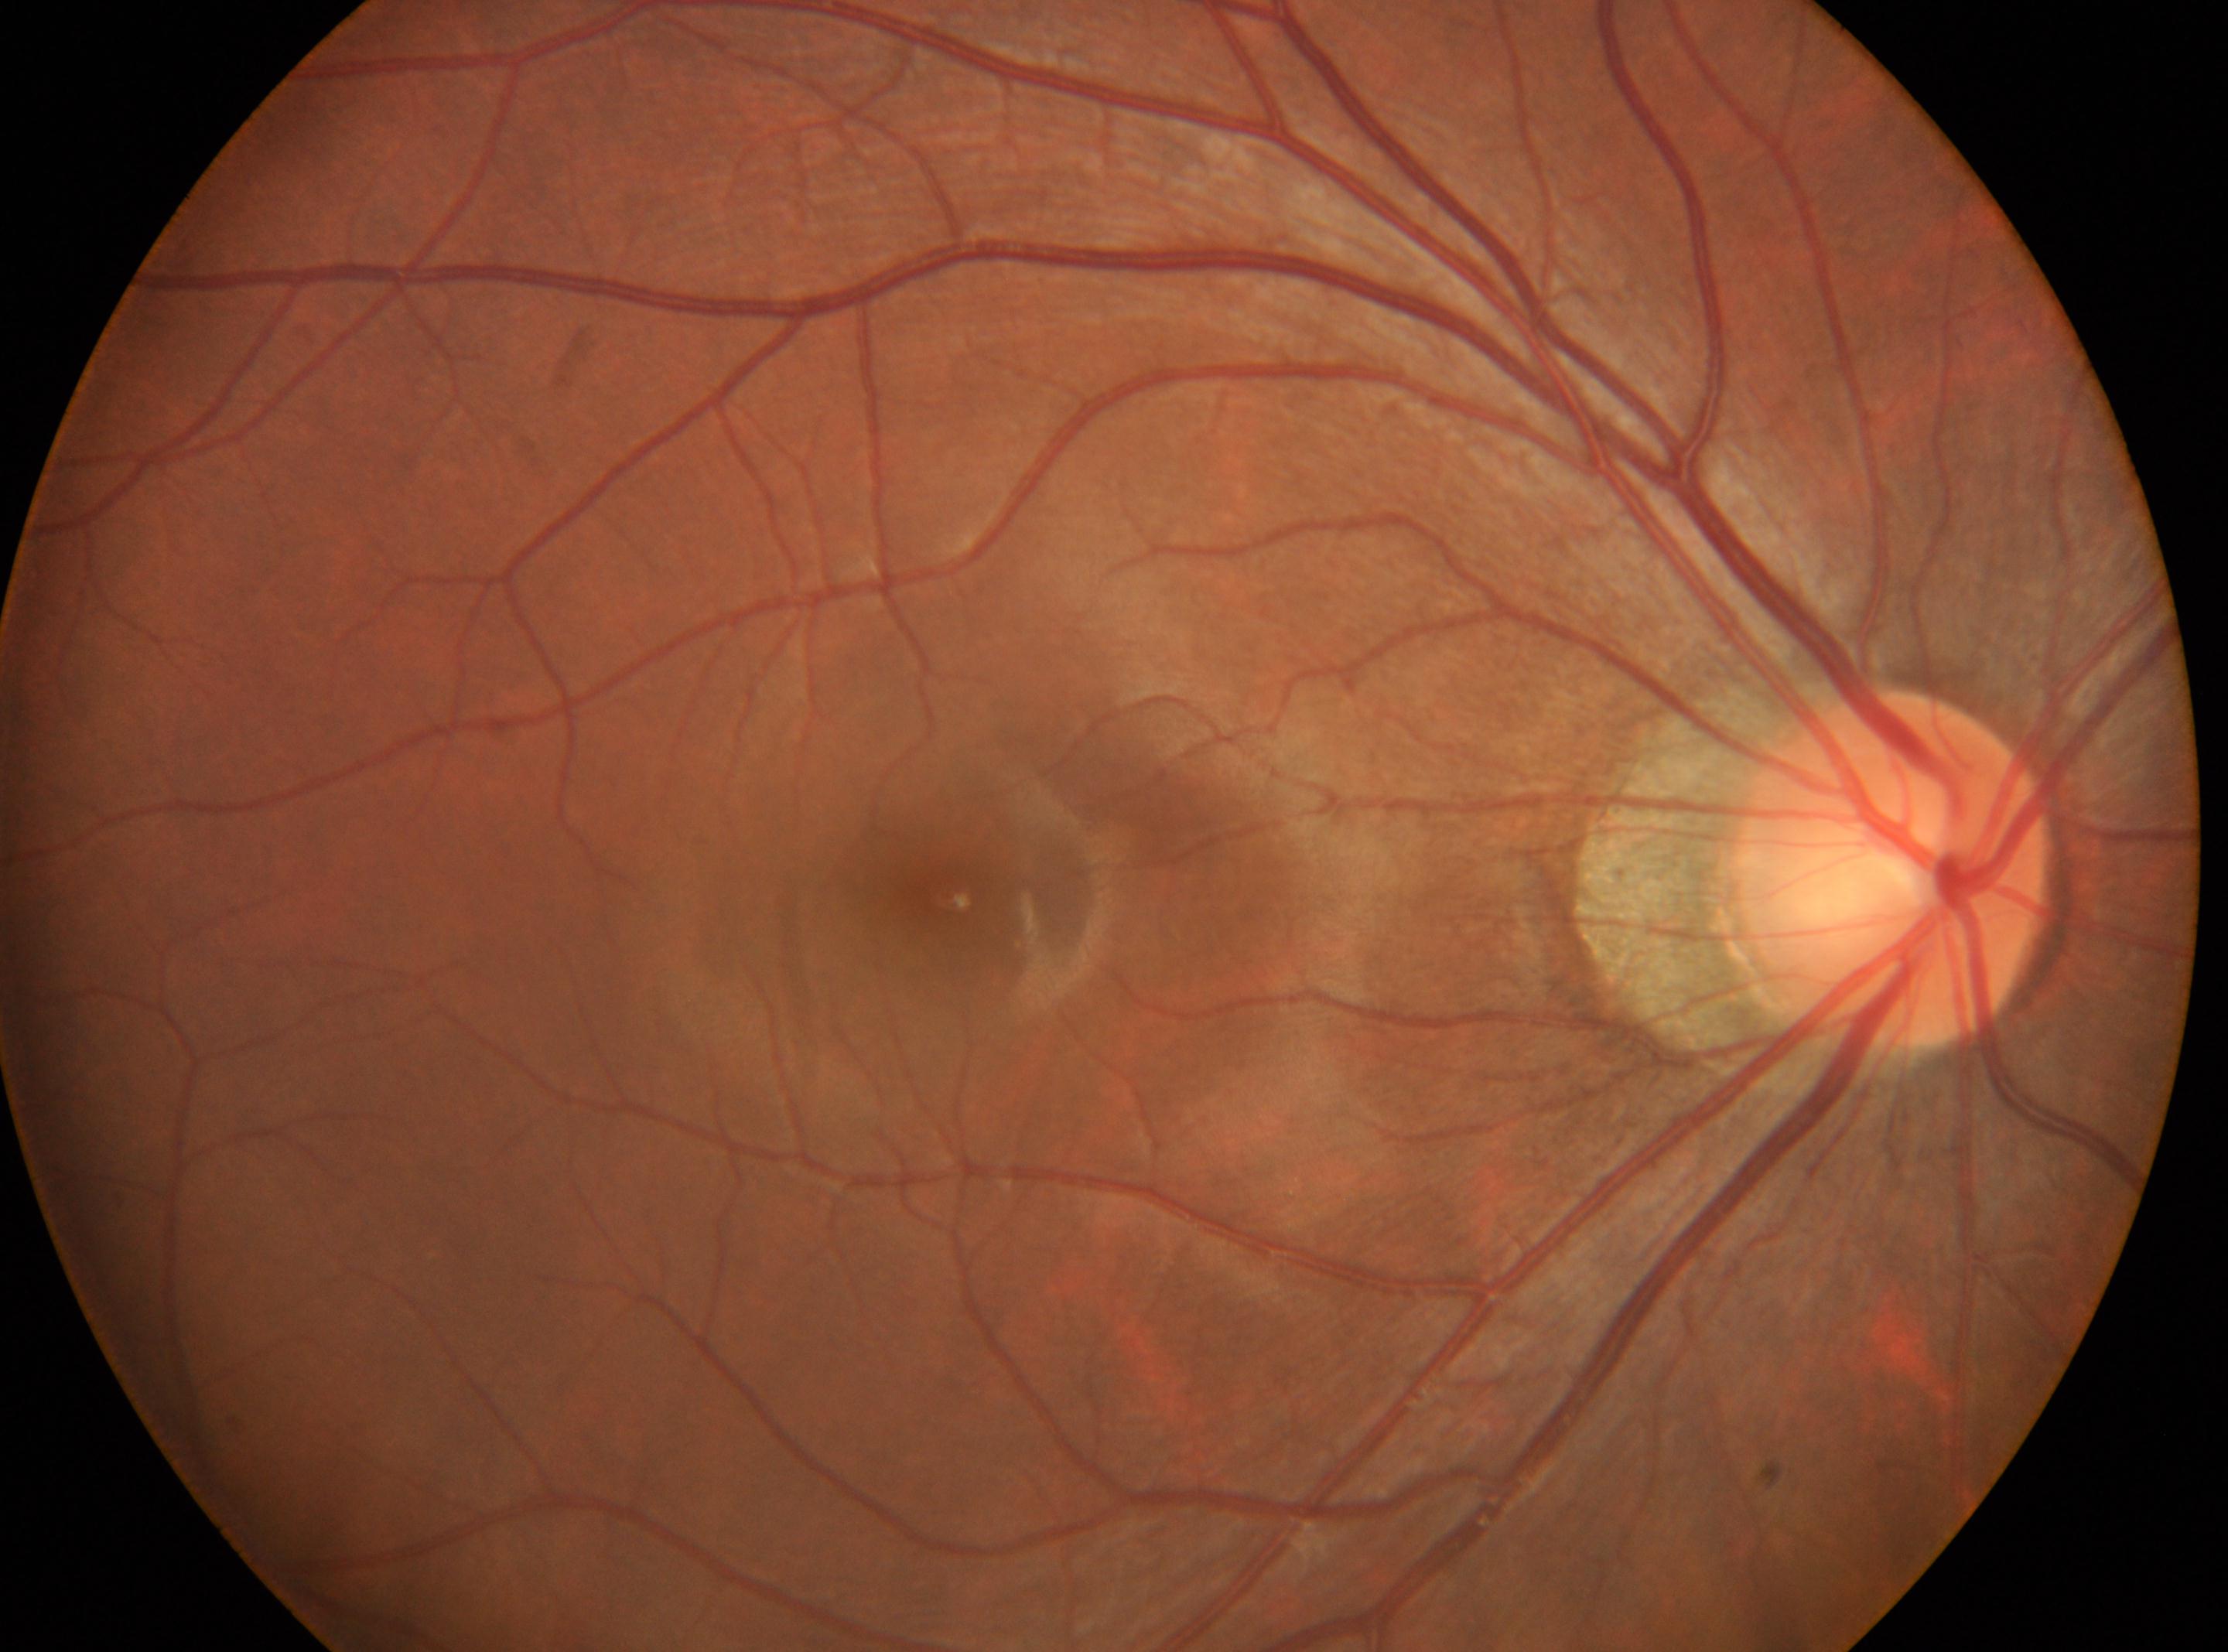
Optic disc center: (1889,868).
No apparent diabetic retinopathy.
Diabetic retinopathy grade is 0.
Fovea located at (948,896).
Eye: right eye.